848 by 848 pixels
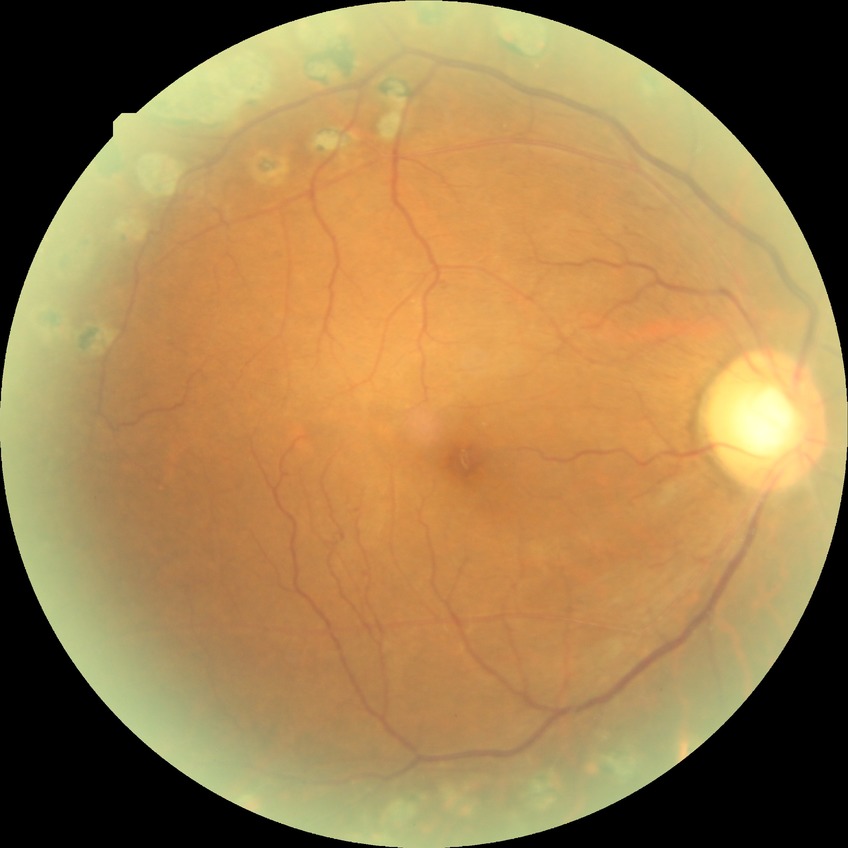

diabetic retinopathy severity = proliferative diabetic retinopathy.